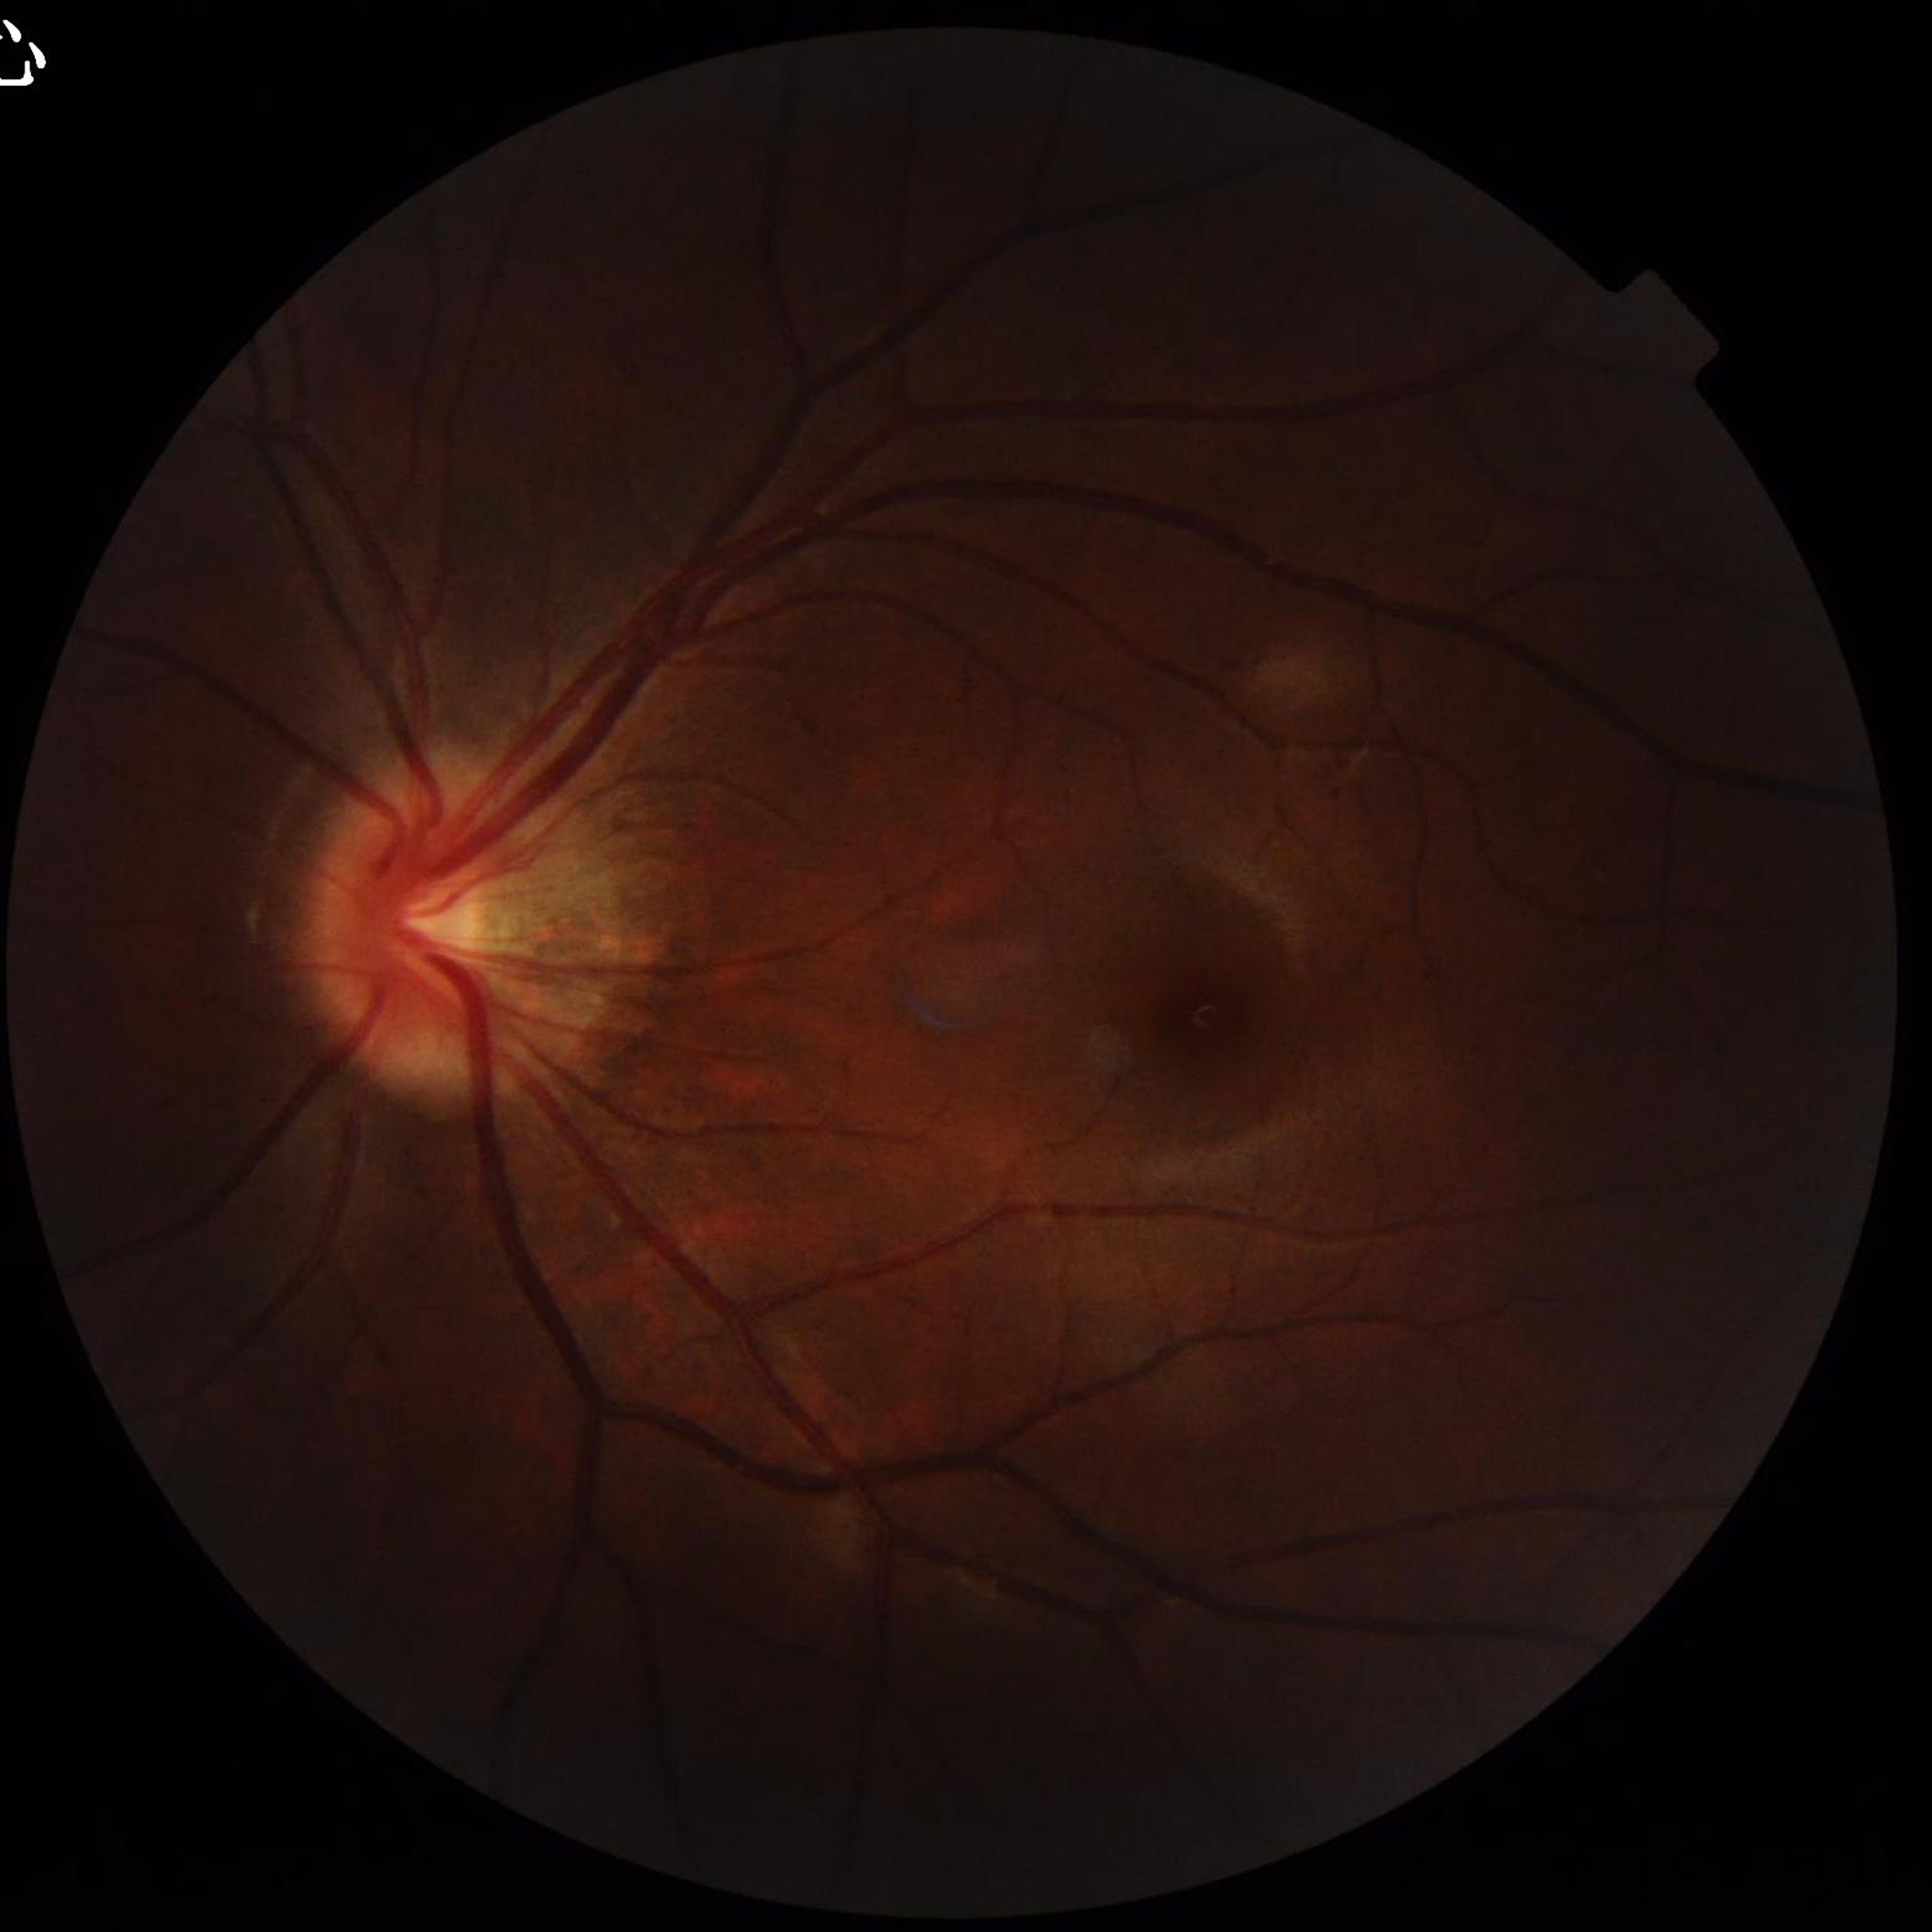
Condition: no AMD, diabetic retinopathy, or glaucoma.